Davis DR grading:
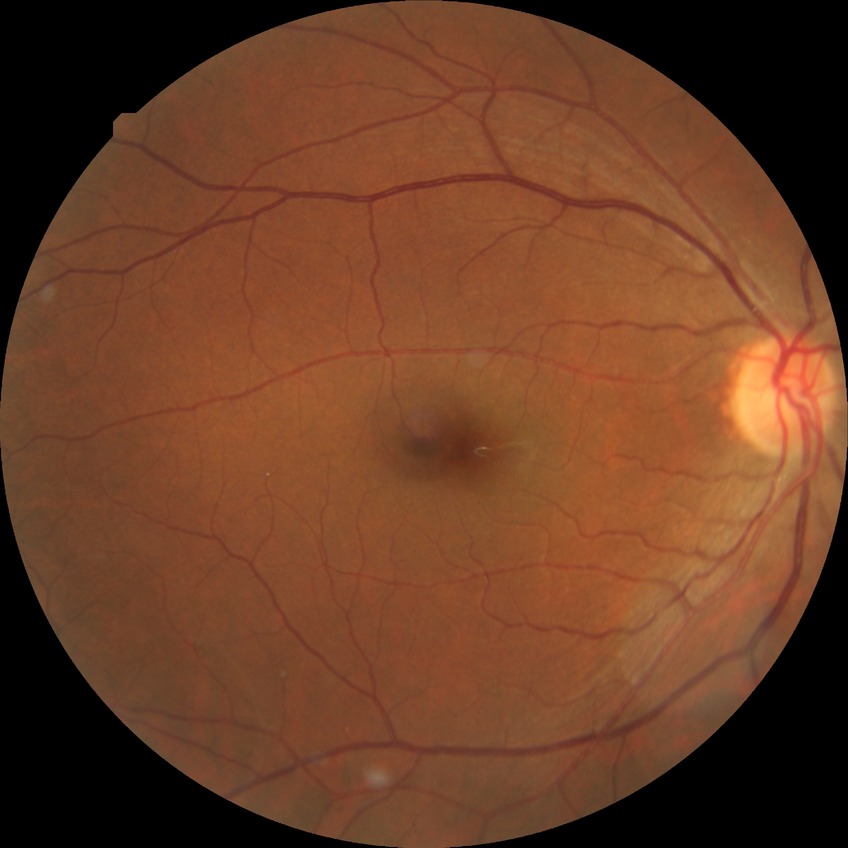 Diabetic retinopathy stage is no diabetic retinopathy.